640 x 480 pixels. Infant wide-field retinal image. Acquired on the Clarity RetCam 3
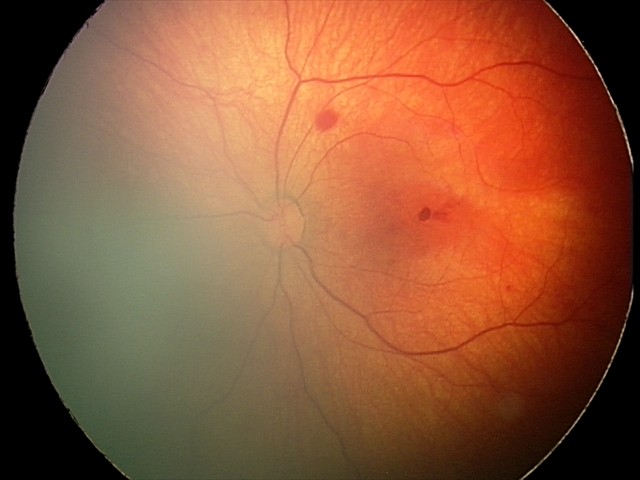

Impression = retinal hemorrhages